50° field of view · color fundus image · 1534x1534px:
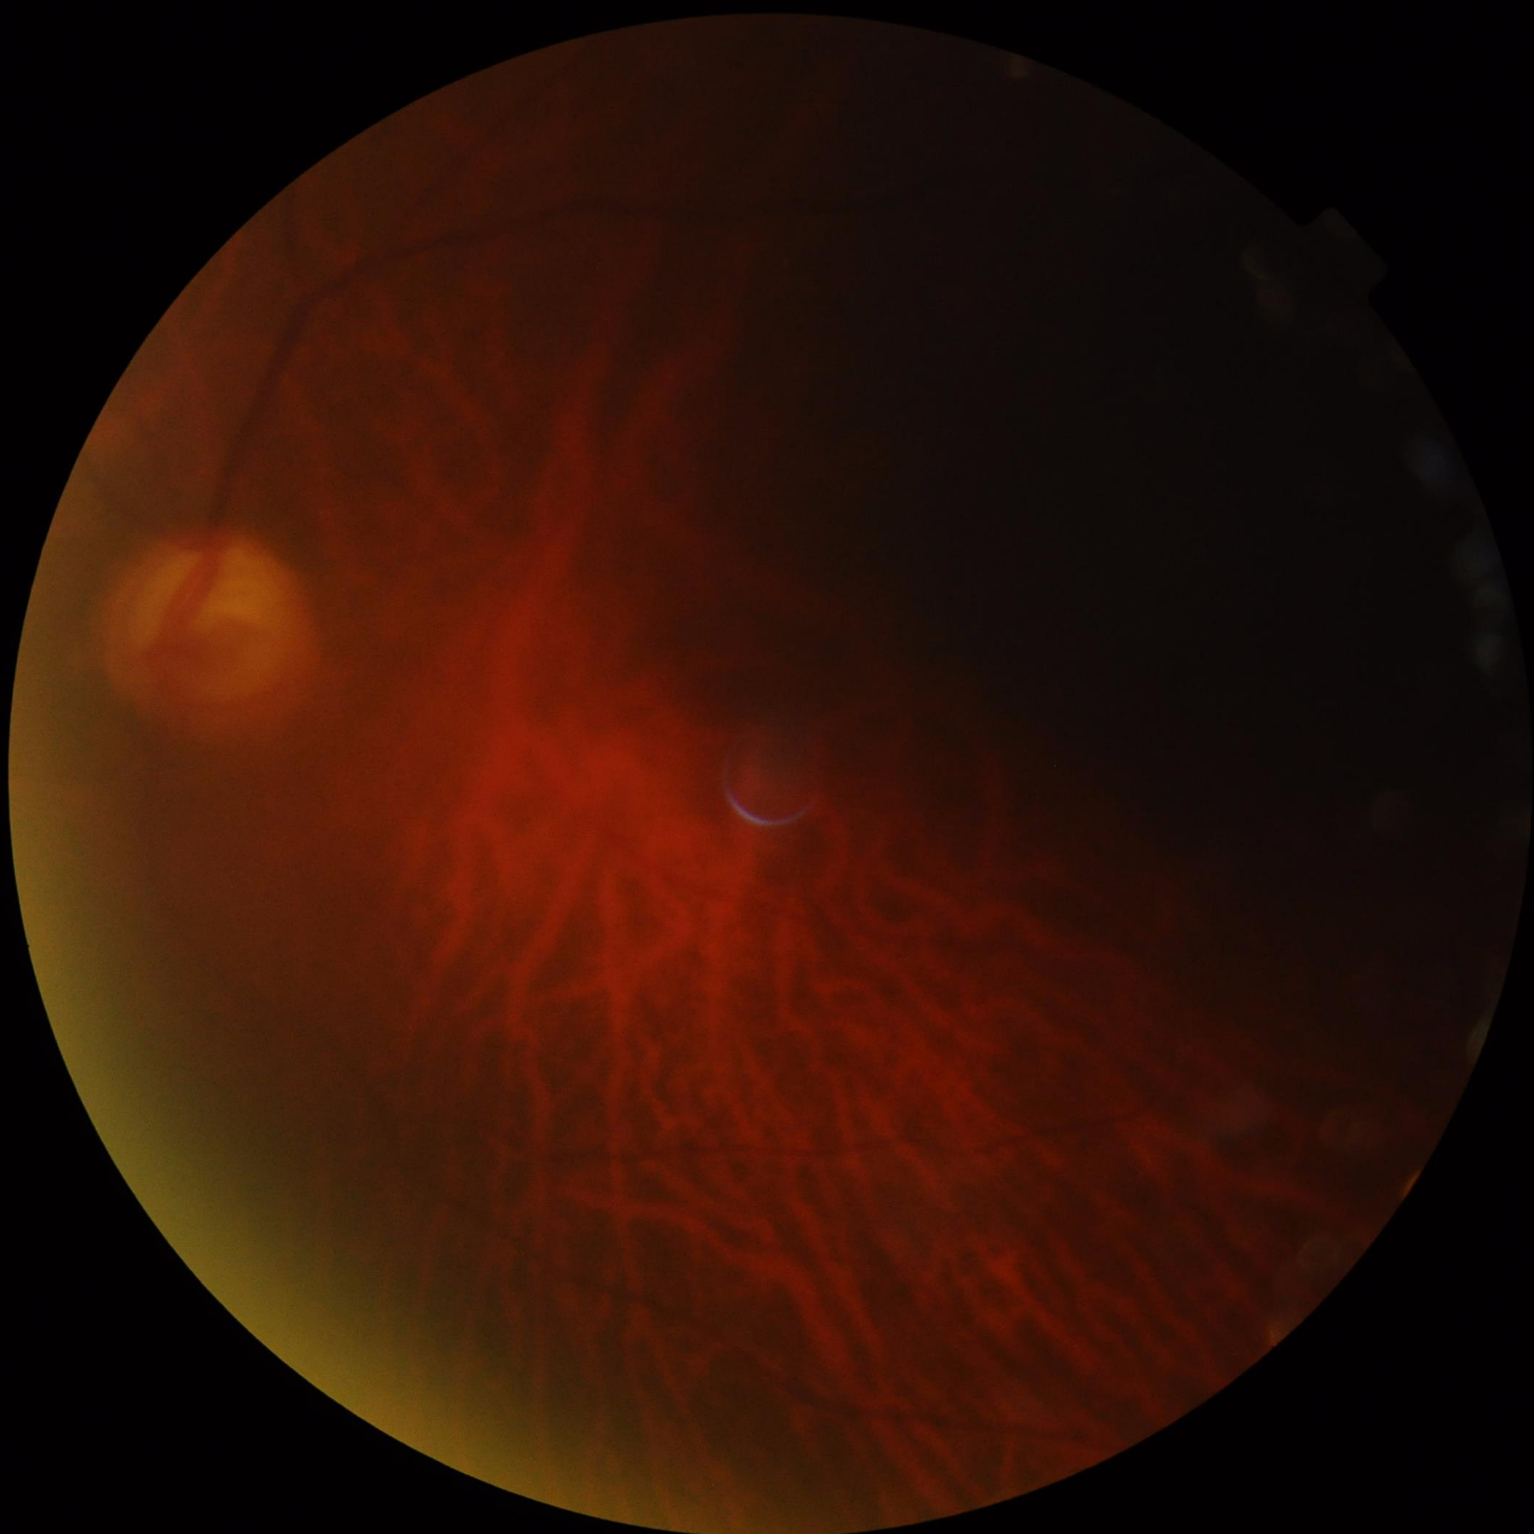 Overall image quality is poor. Illumination is uneven. Contrast is low. The image is blurry.